2048x1536:
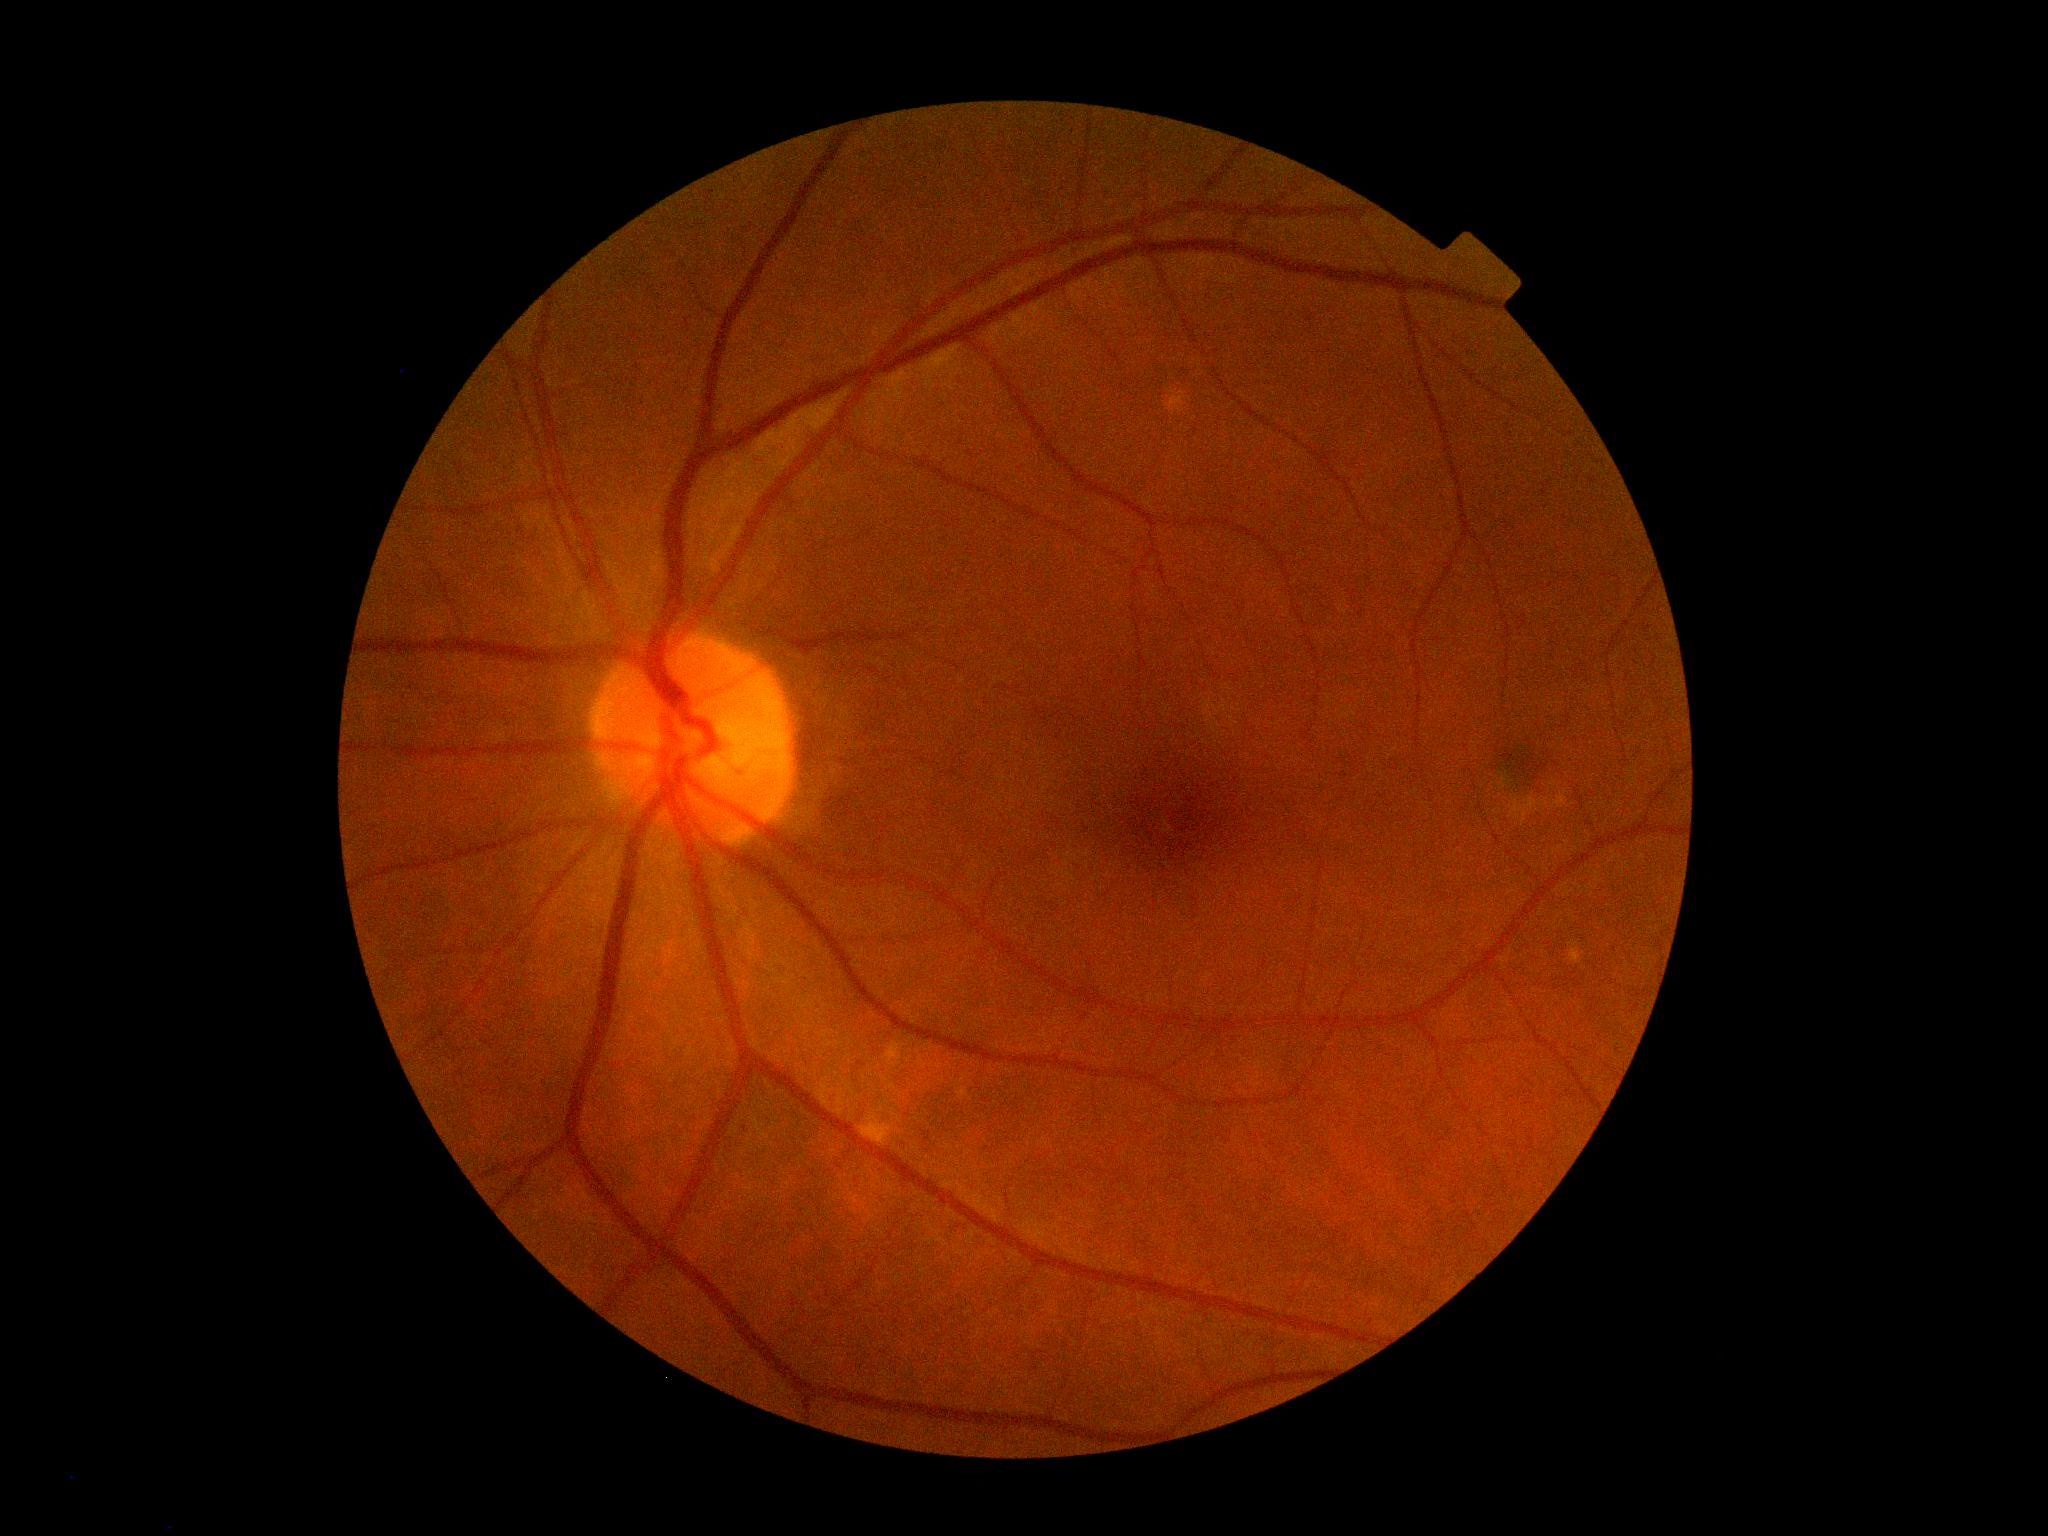

Diabetic retinopathy is grade 2.